Modified Davis classification.
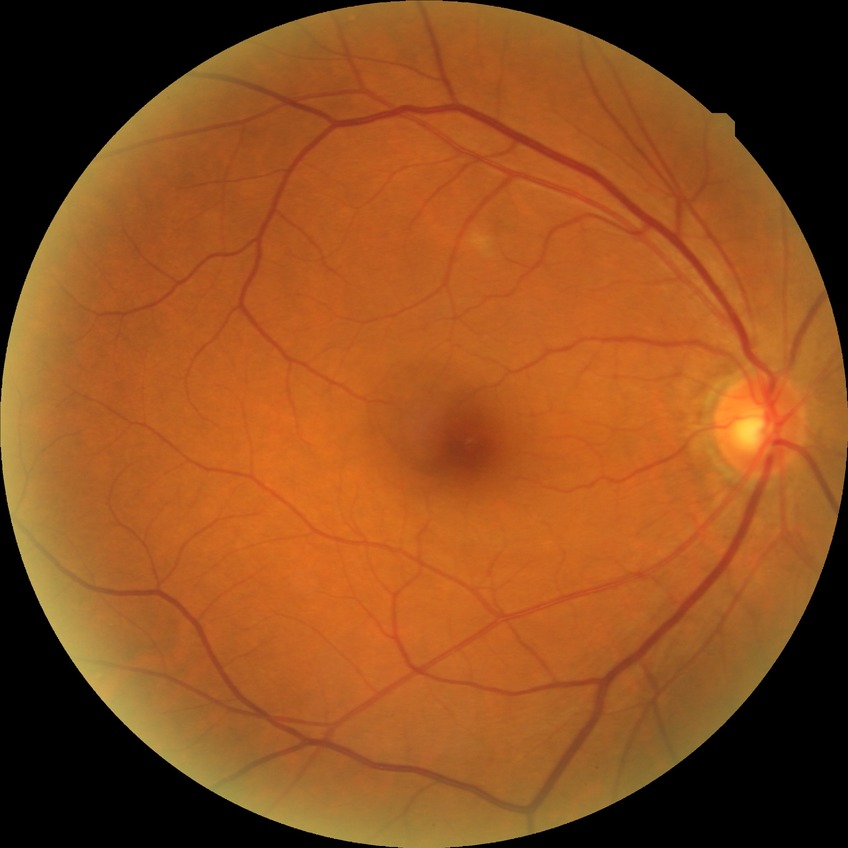 diabetic retinopathy (DR)=SDR (simple diabetic retinopathy).